FOV: 45 degrees — 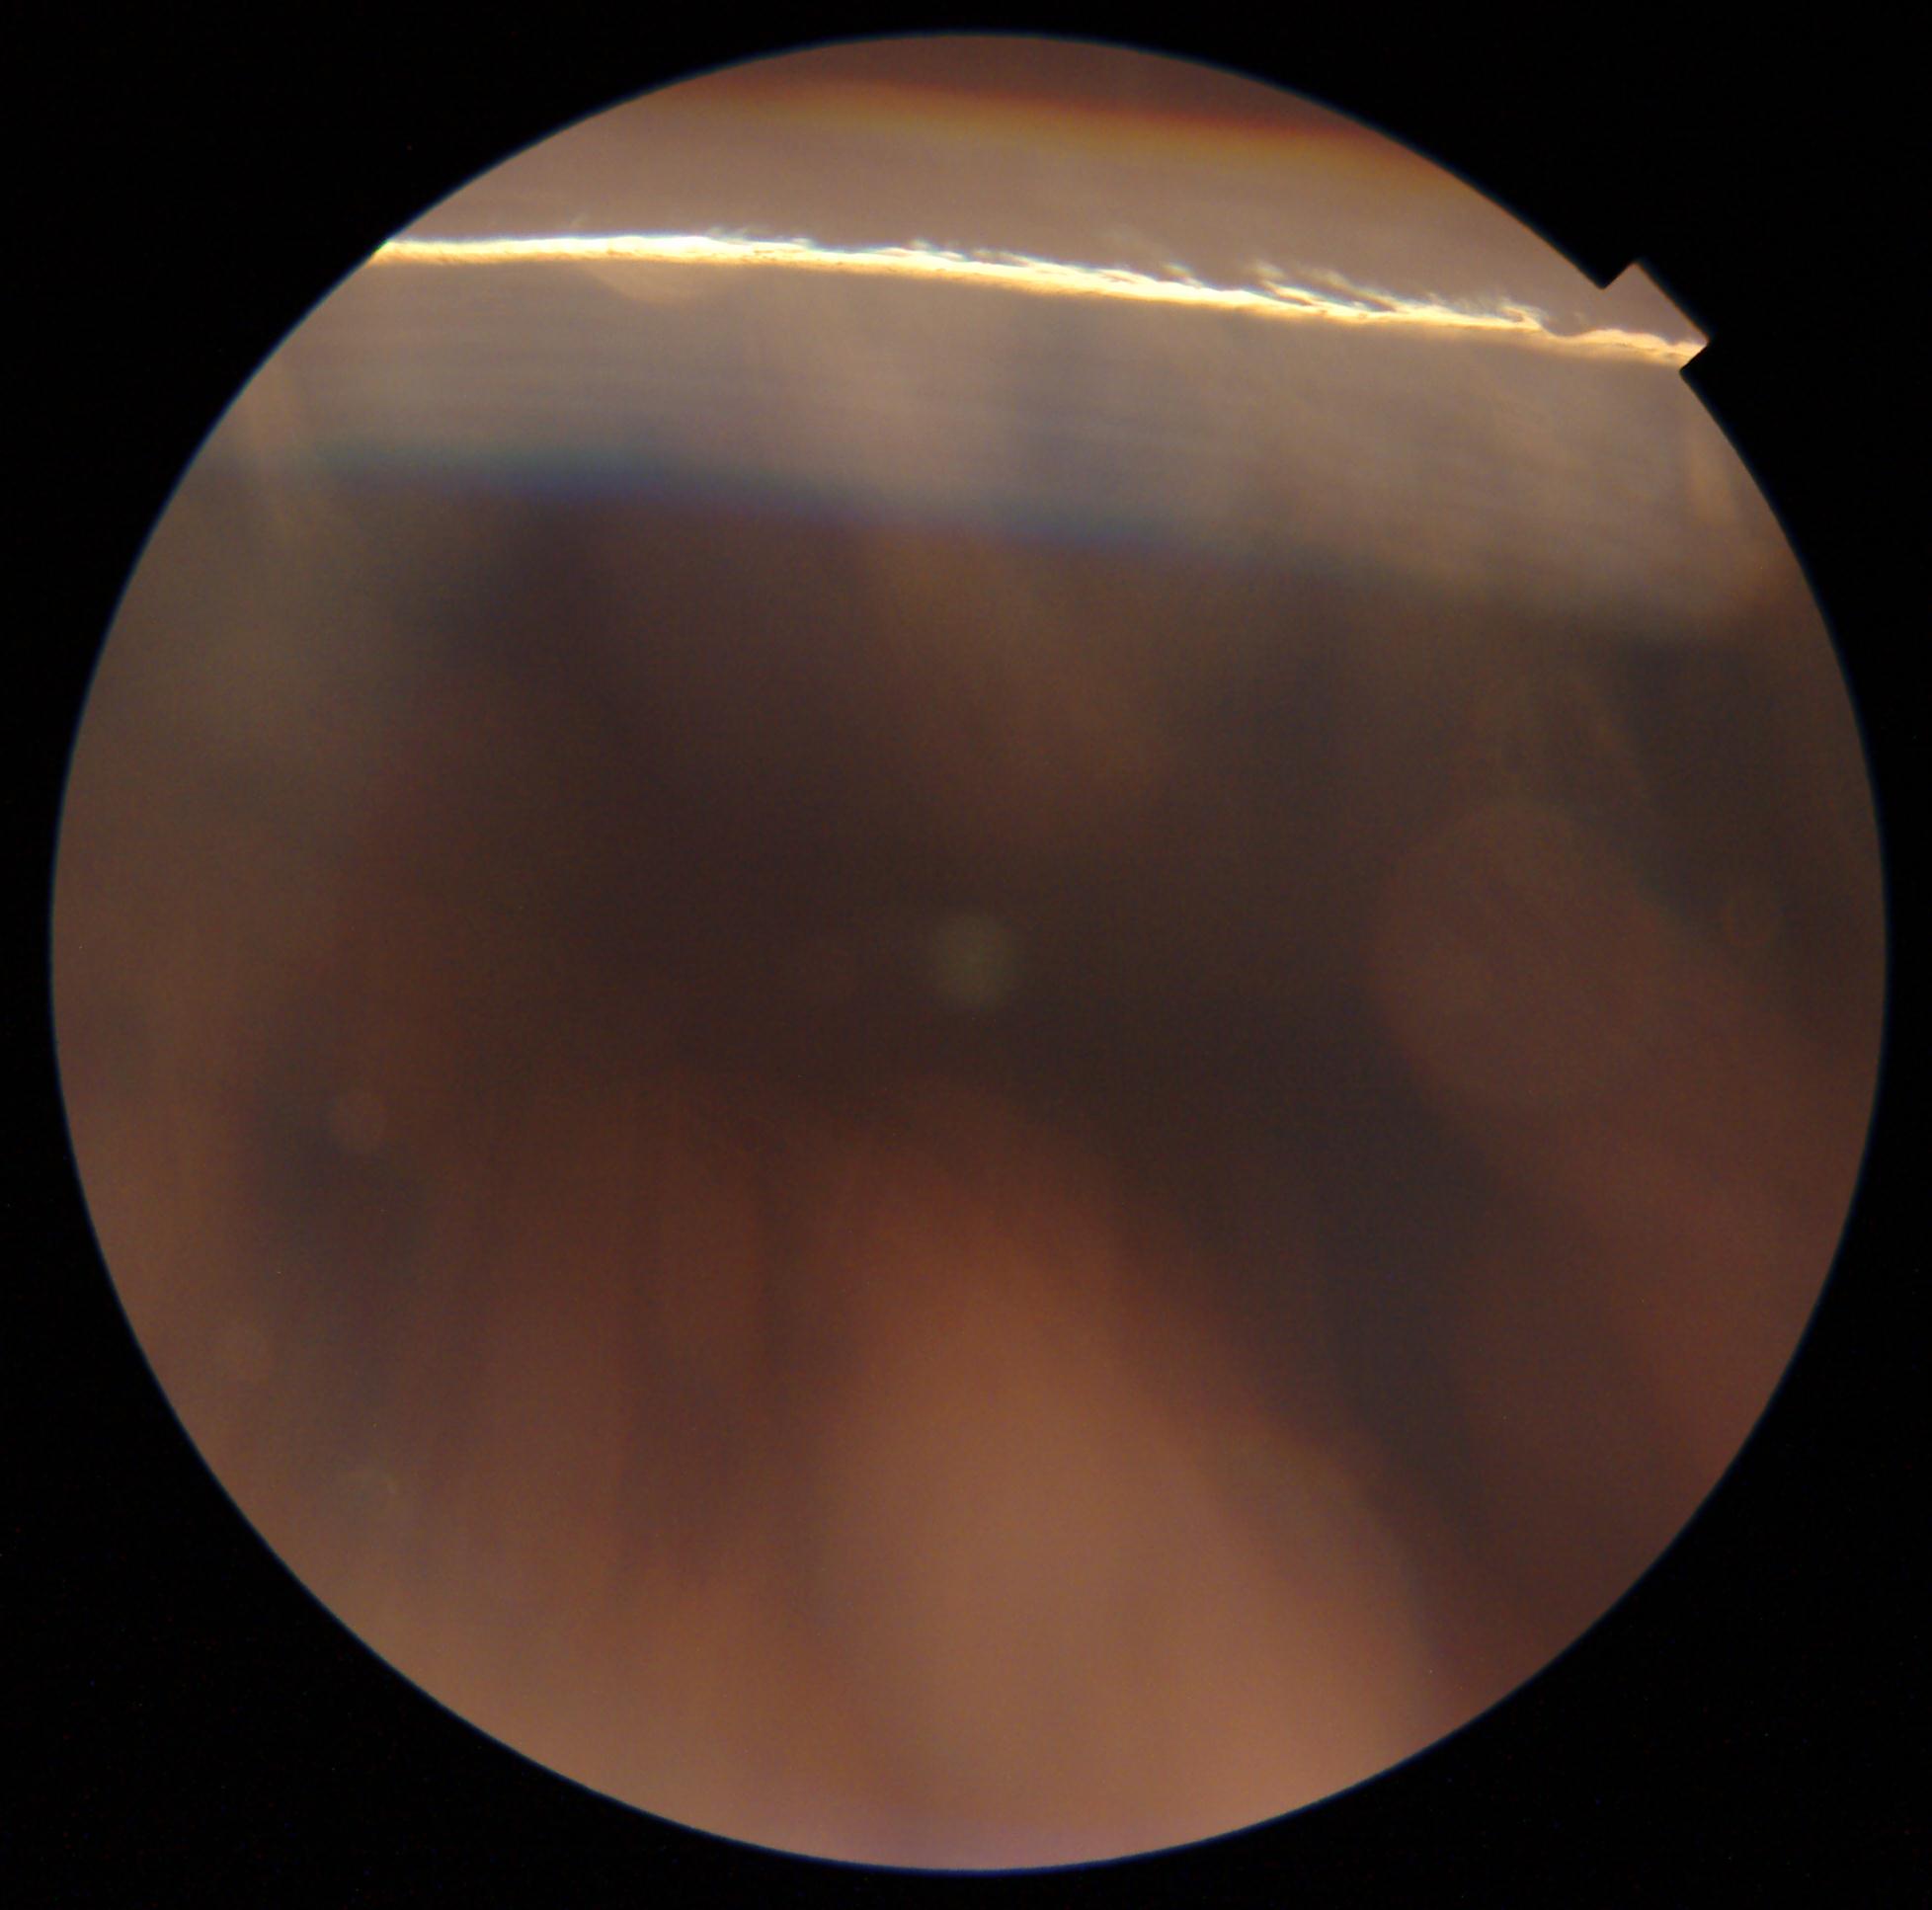
DR grade: ungradable due to poor image quality.